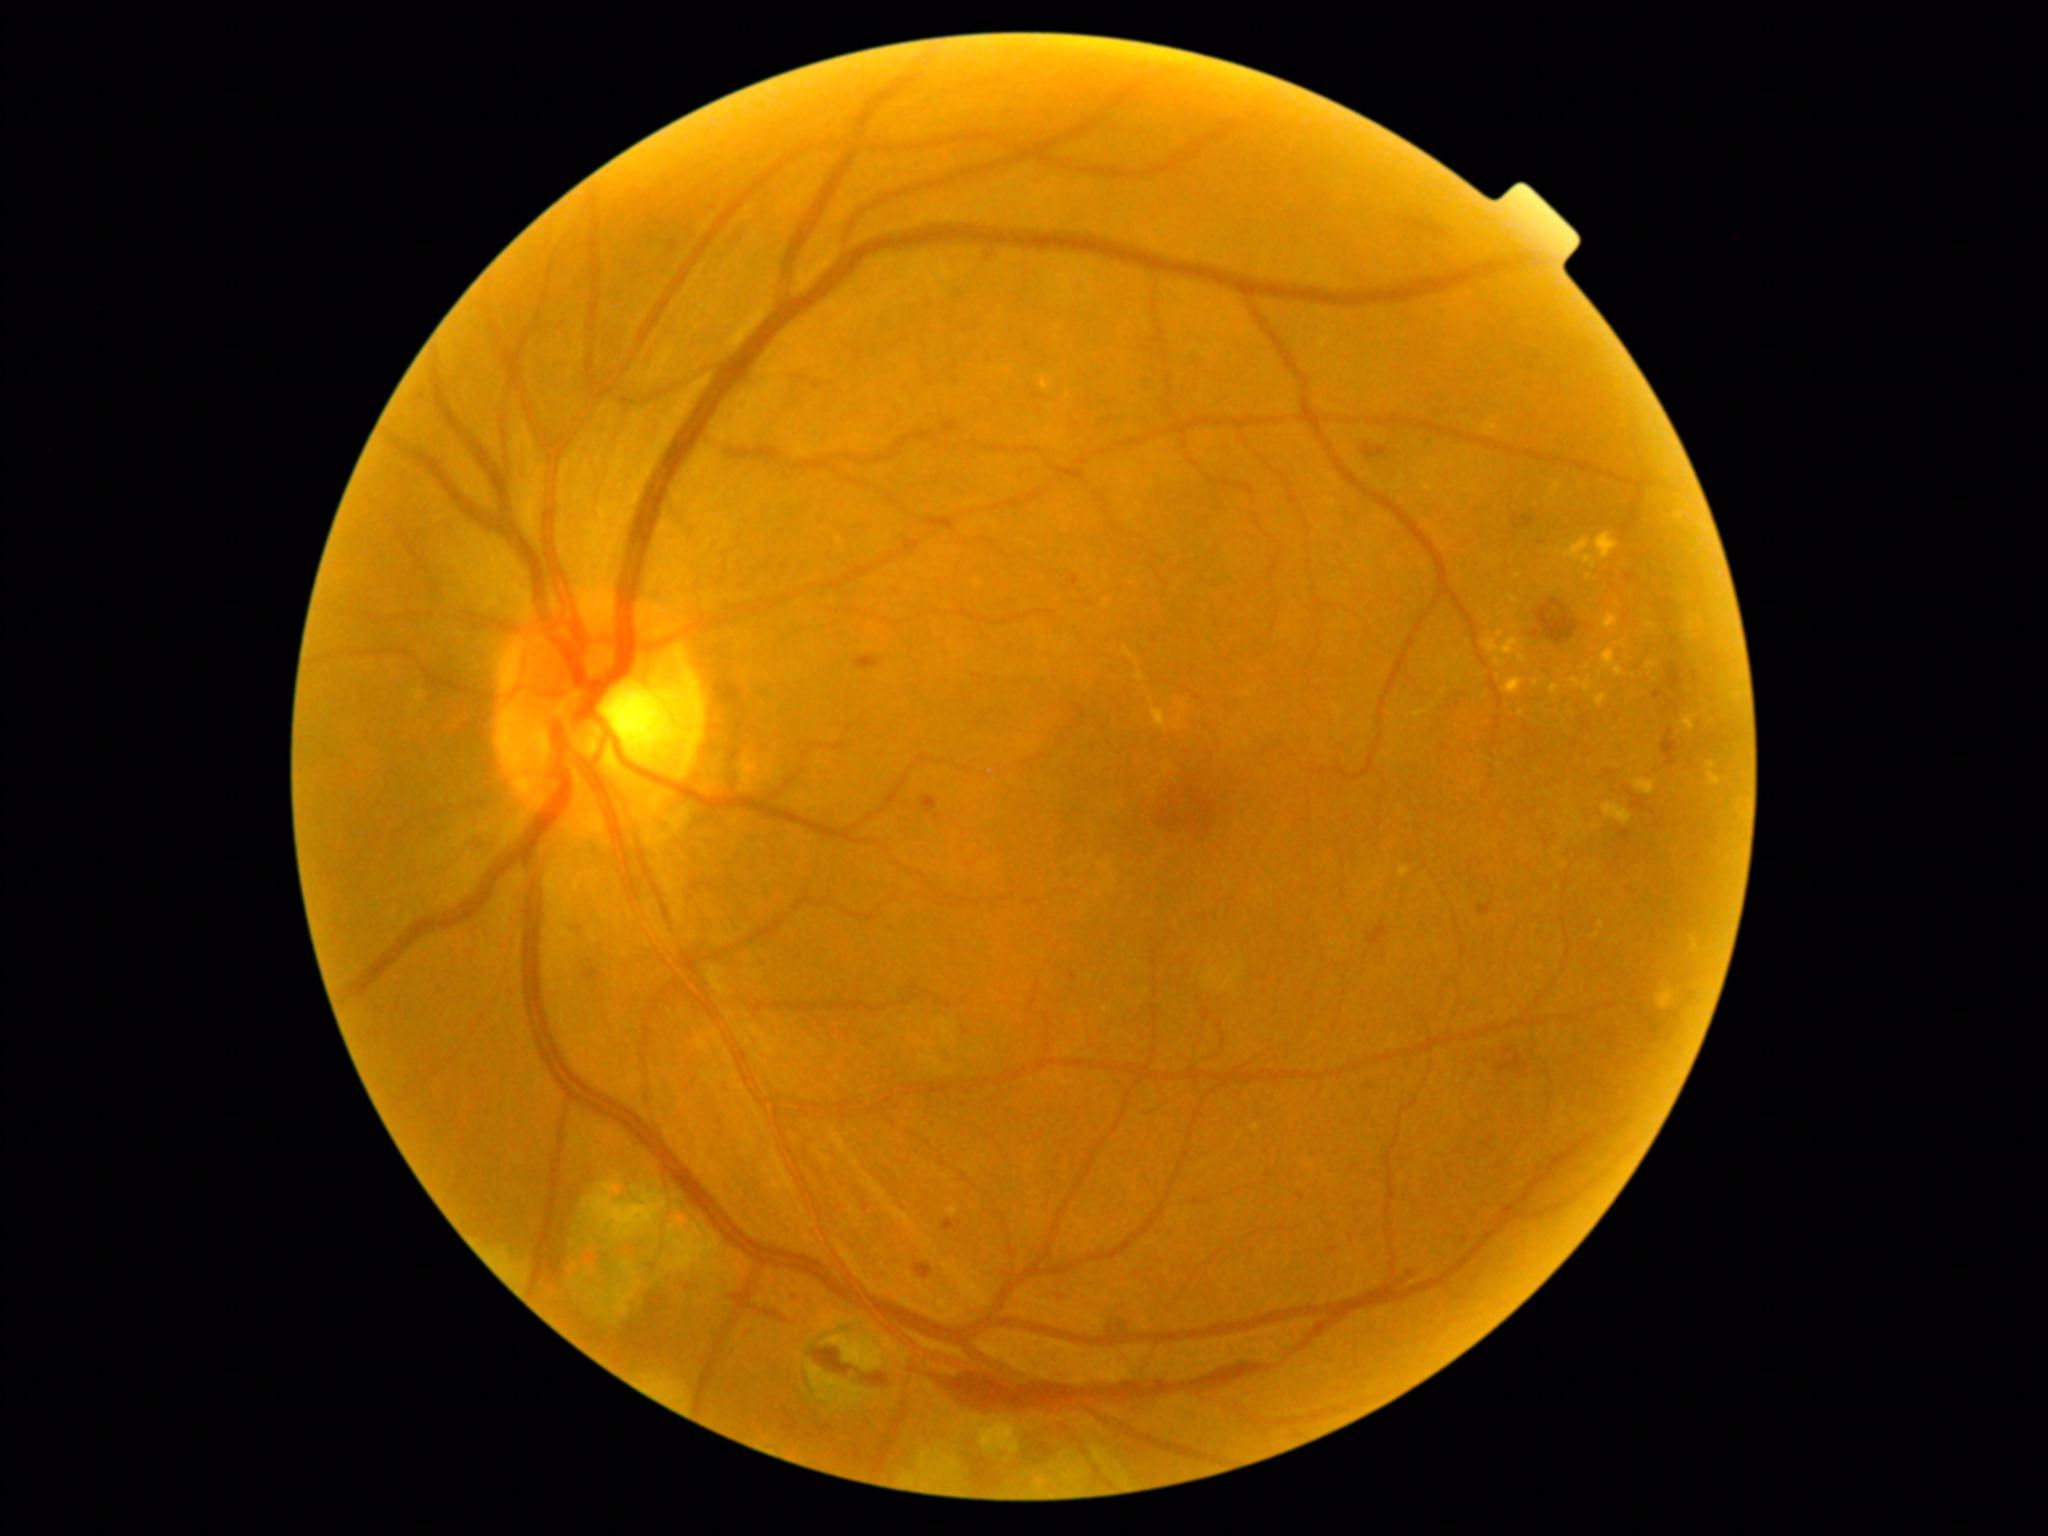 DR stage is grade 2 — more than just microaneurysms but less than severe NPDR
A subset of detected lesions:
HEs (more not shown): (x1=1661, y1=727, x2=1680, y2=767), (x1=1667, y1=667, x2=1685, y2=691), (x1=1477, y1=903, x2=1493, y2=916), (x1=1364, y1=443, x2=1390, y2=459), (x1=813, y1=1349, x2=852, y2=1375), (x1=1367, y1=922, x2=1388, y2=946), (x1=1407, y1=1270, x2=1417, y2=1279), (x1=1668, y1=637, x2=1681, y2=648), (x1=1512, y1=515, x2=1535, y2=530), (x1=1535, y1=601, x2=1579, y2=645), (x1=1107, y1=1316, x2=1126, y2=1332)
Additional small HEs near [x=1653, y=813]